Non-mydriatic acquisition: 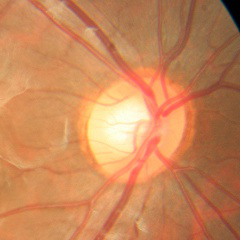

Glaucoma diagnosis = no glaucoma.